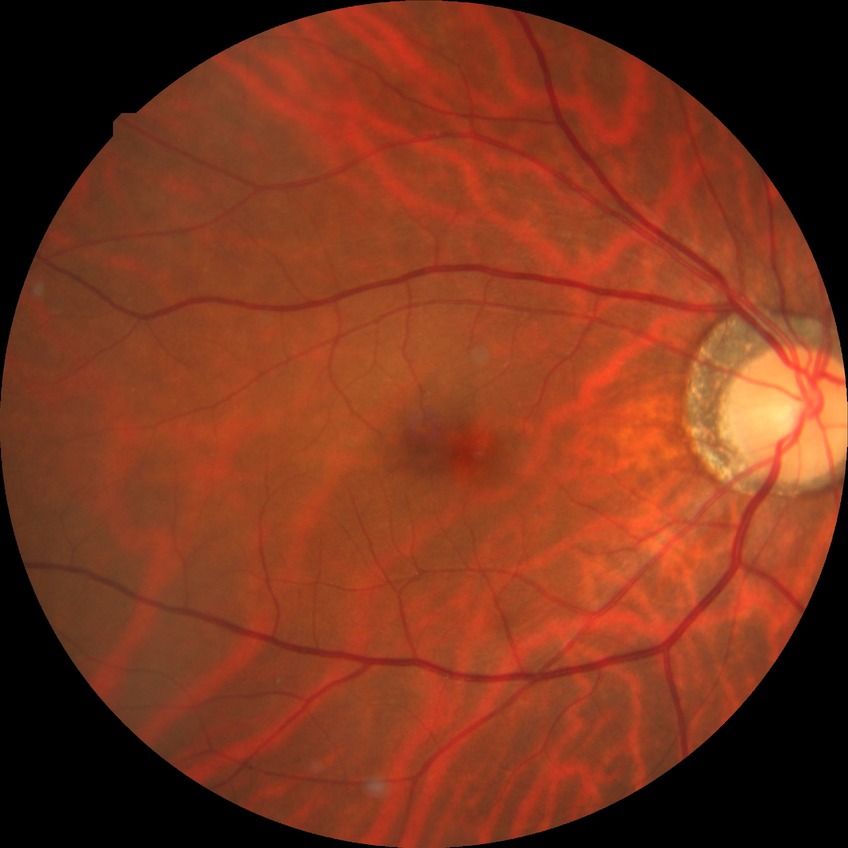

Diabetic retinopathy (DR) is no diabetic retinopathy (NDR).